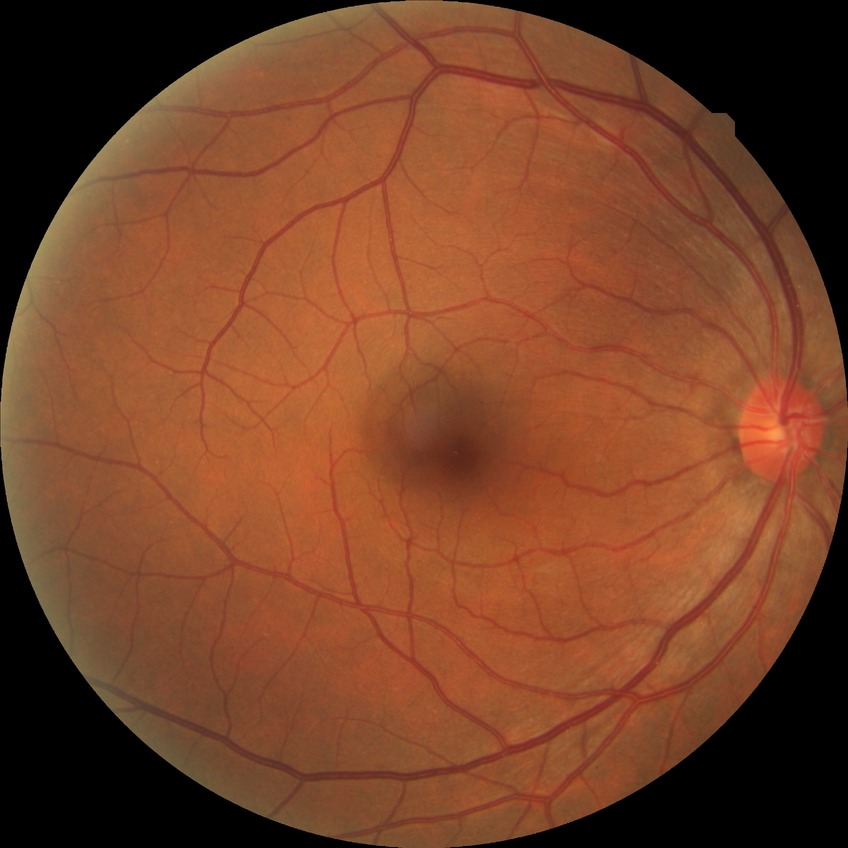

Diabetic retinopathy (DR) is no diabetic retinopathy (NDR).